45° FOV; color fundus image:
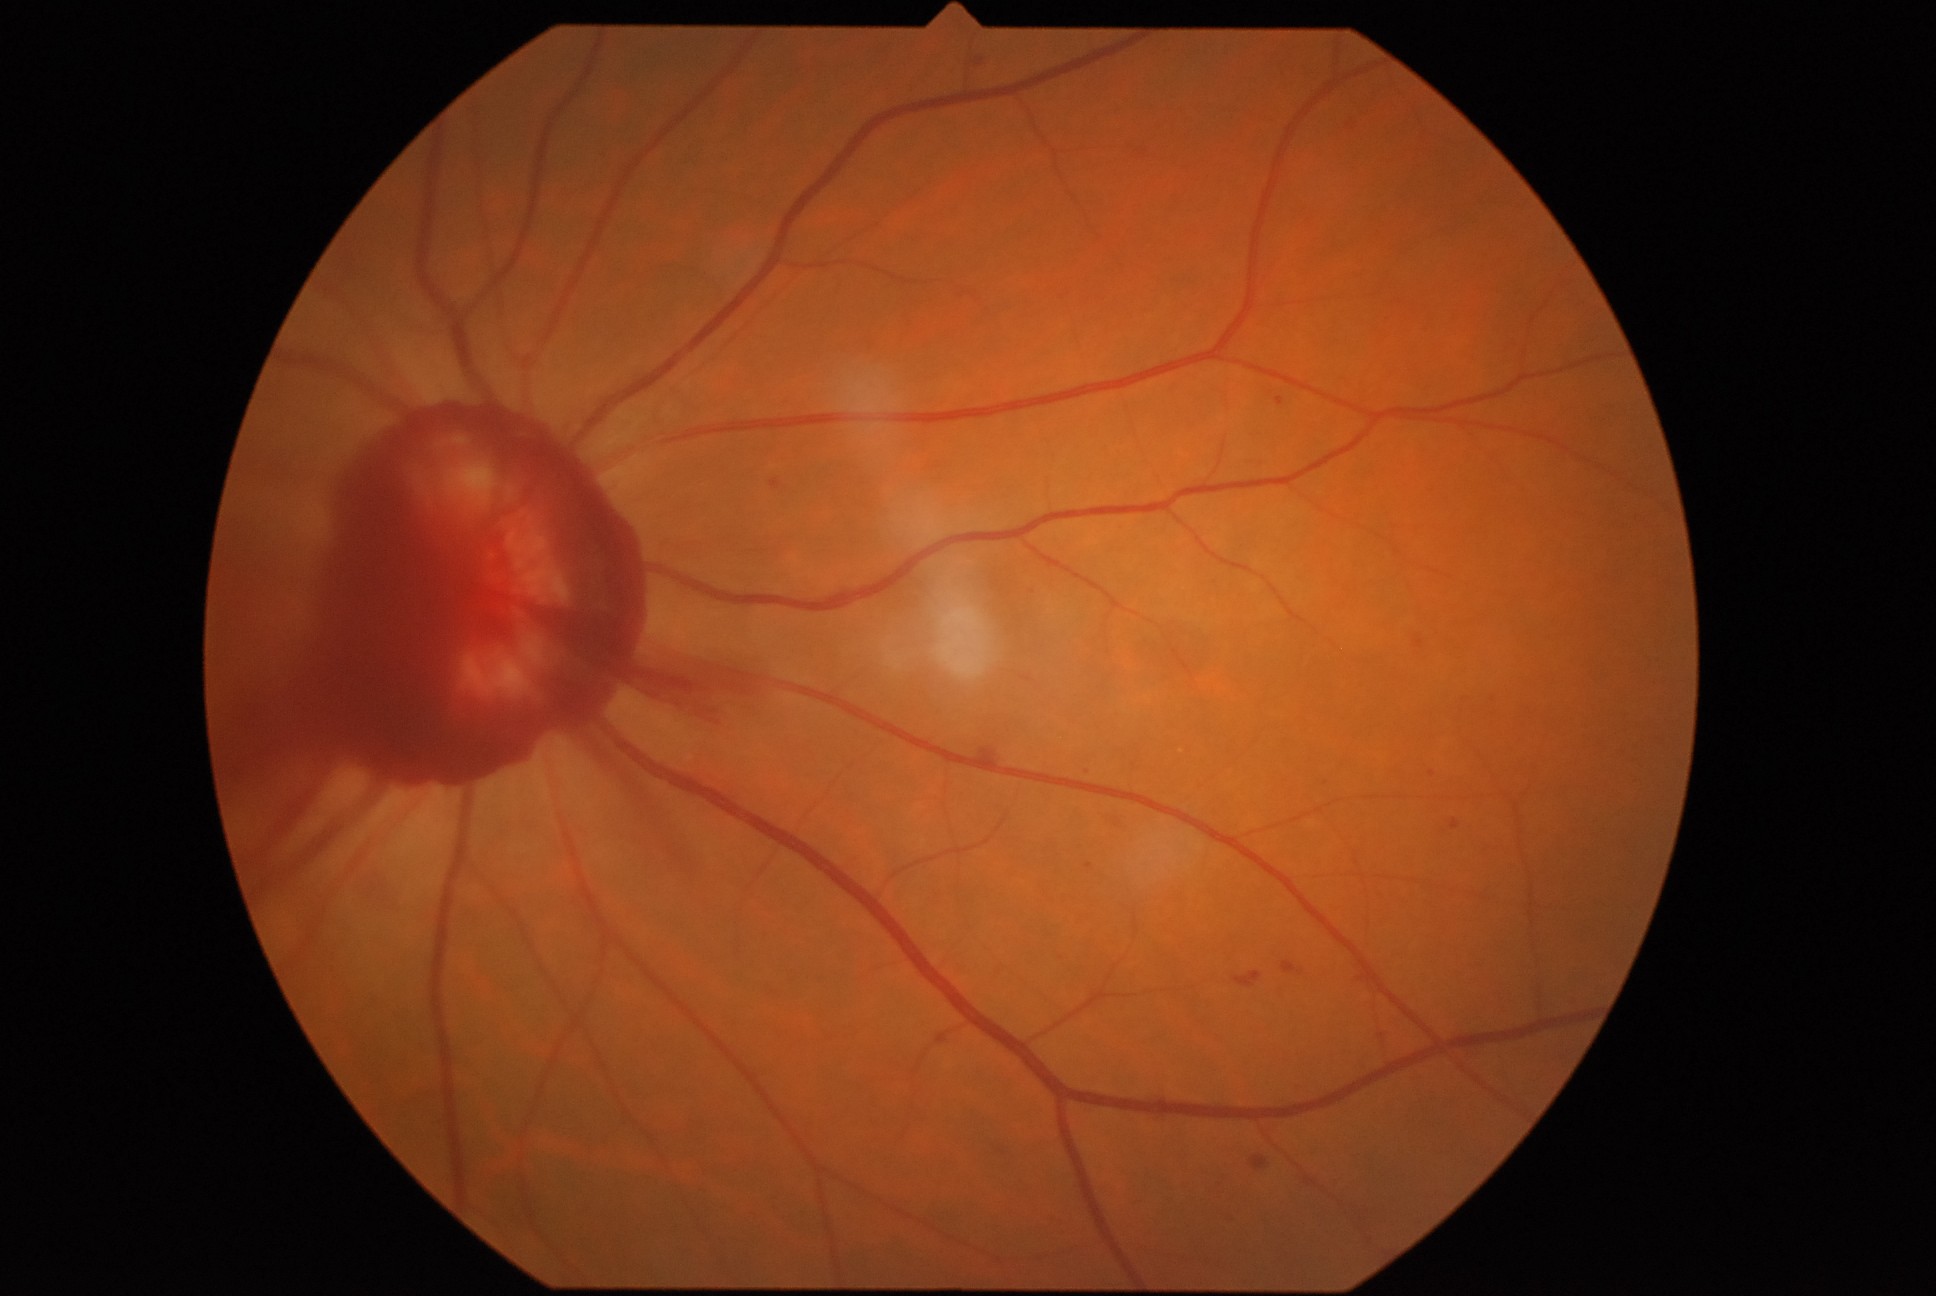 DR severity: grade 4 — neovascularization and/or vitreous/pre-retinal hemorrhage.